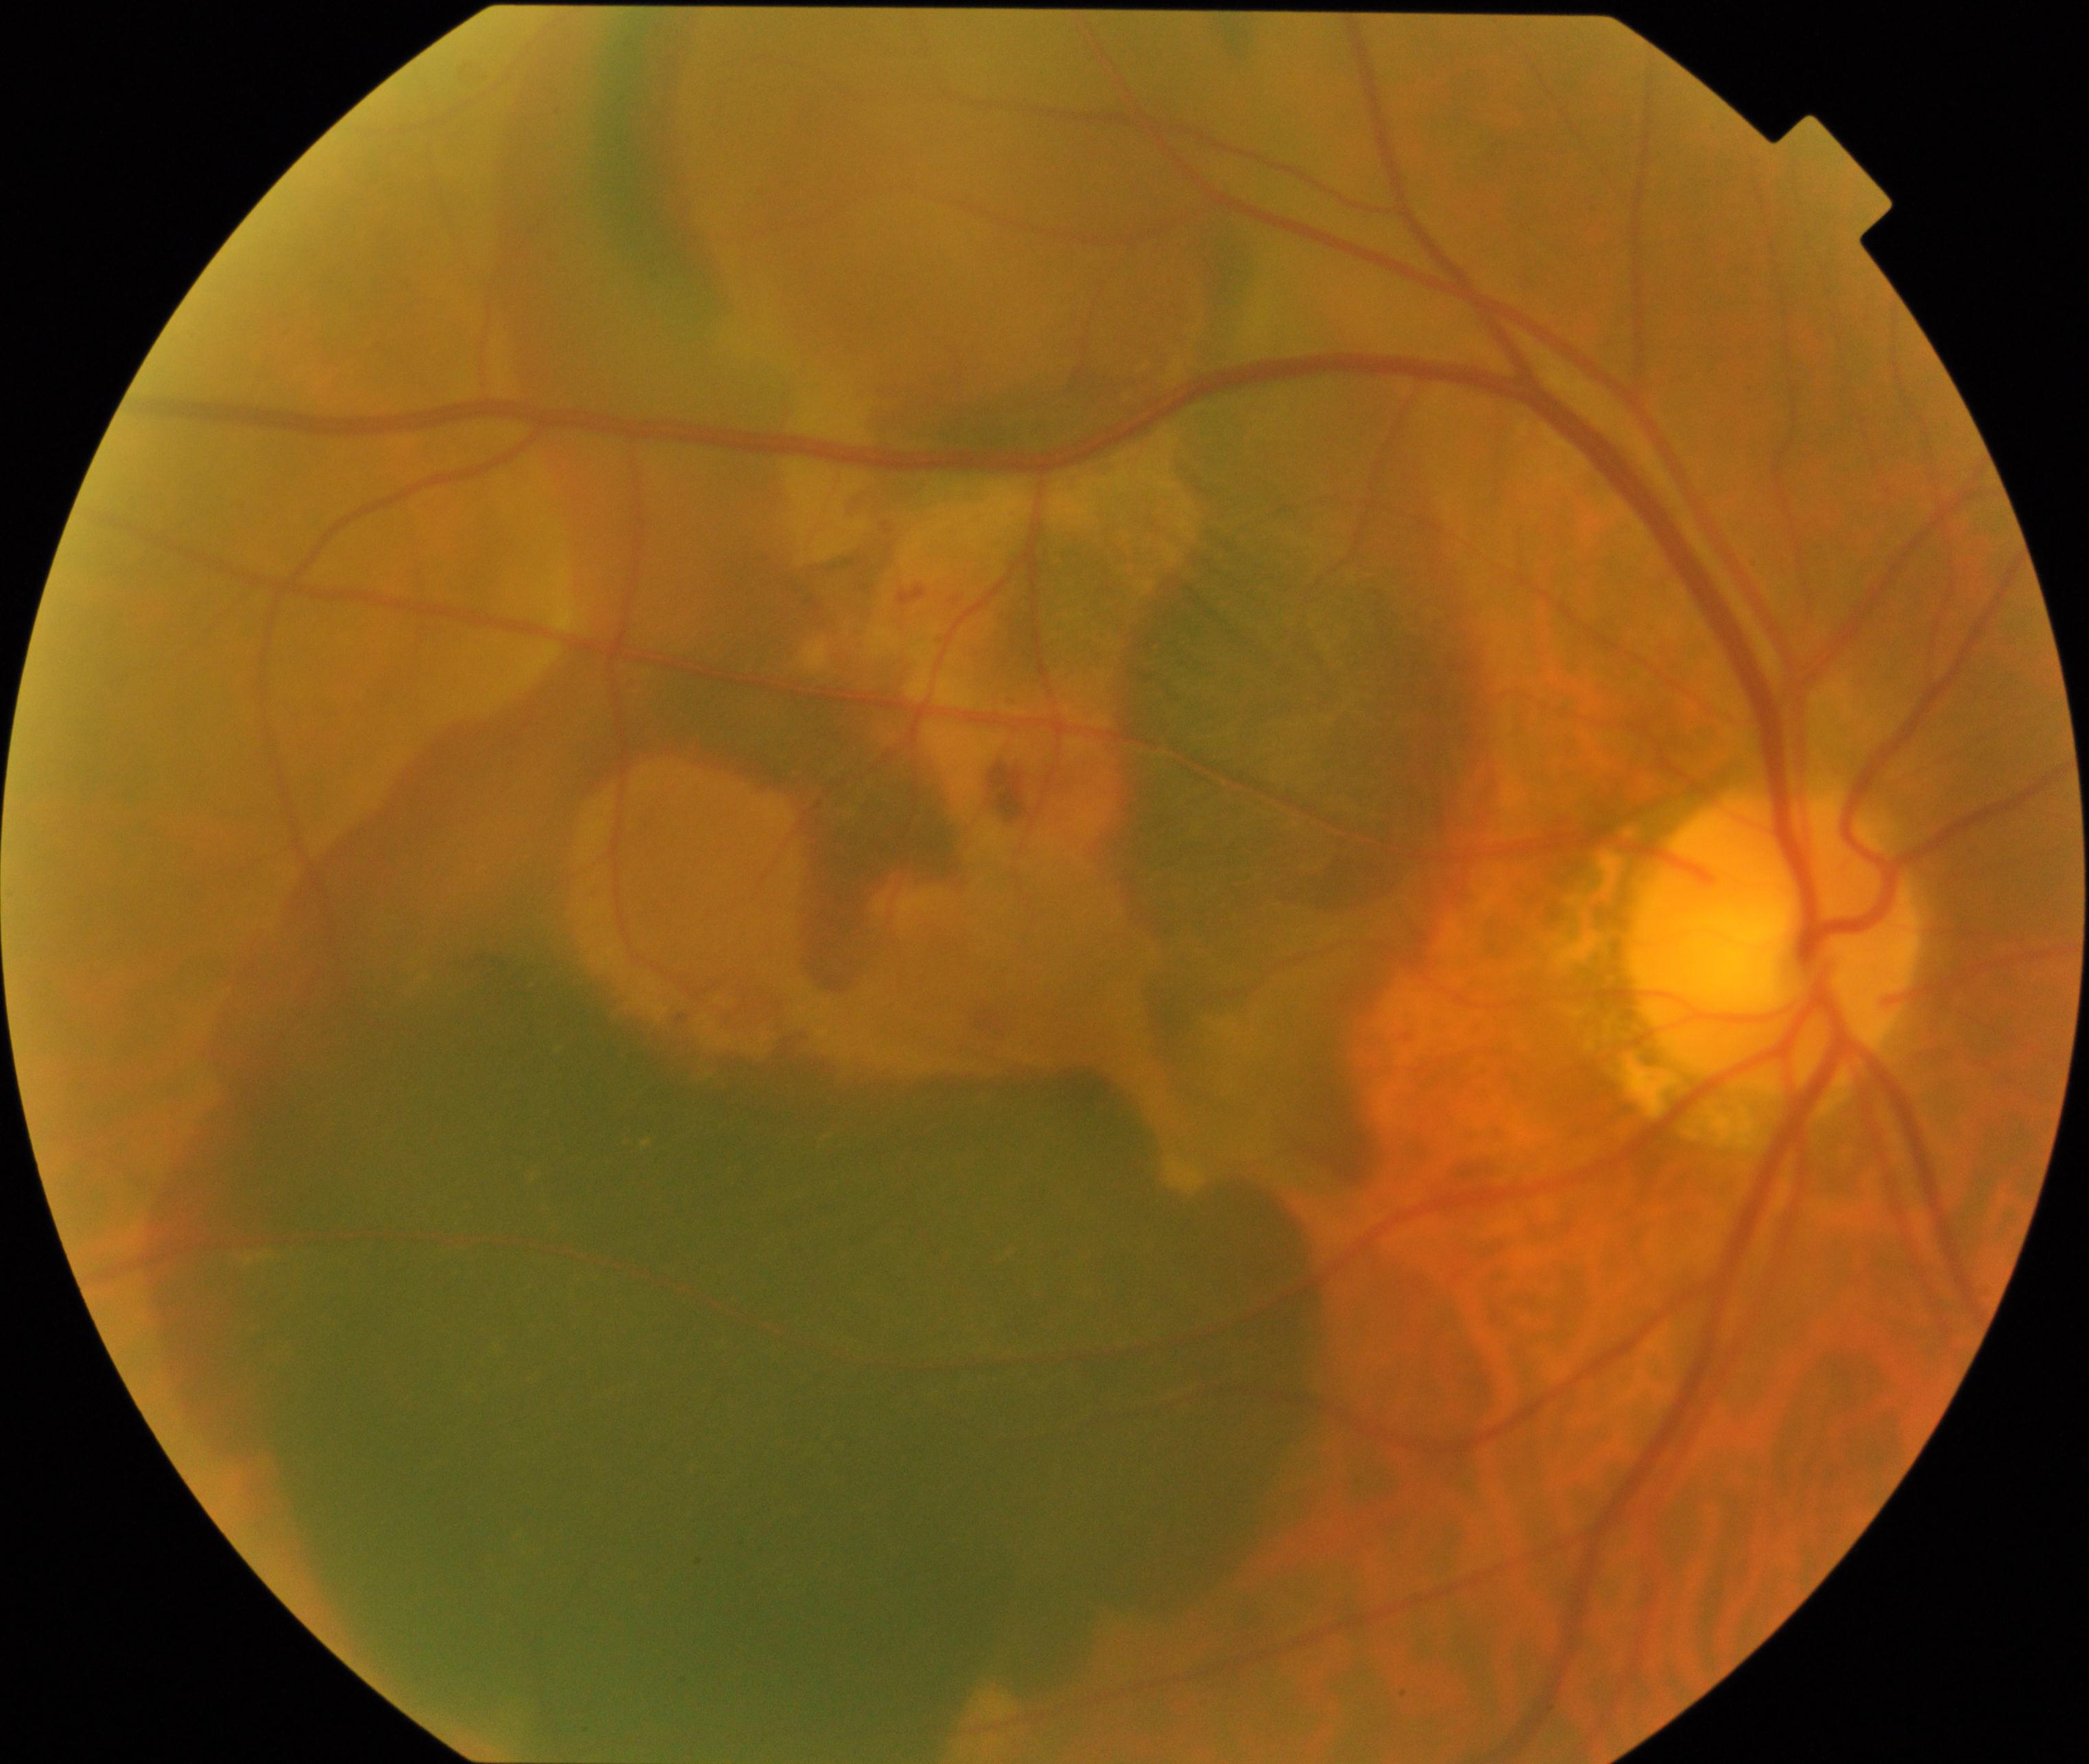

Fundus appearance consistent with maculopathy.